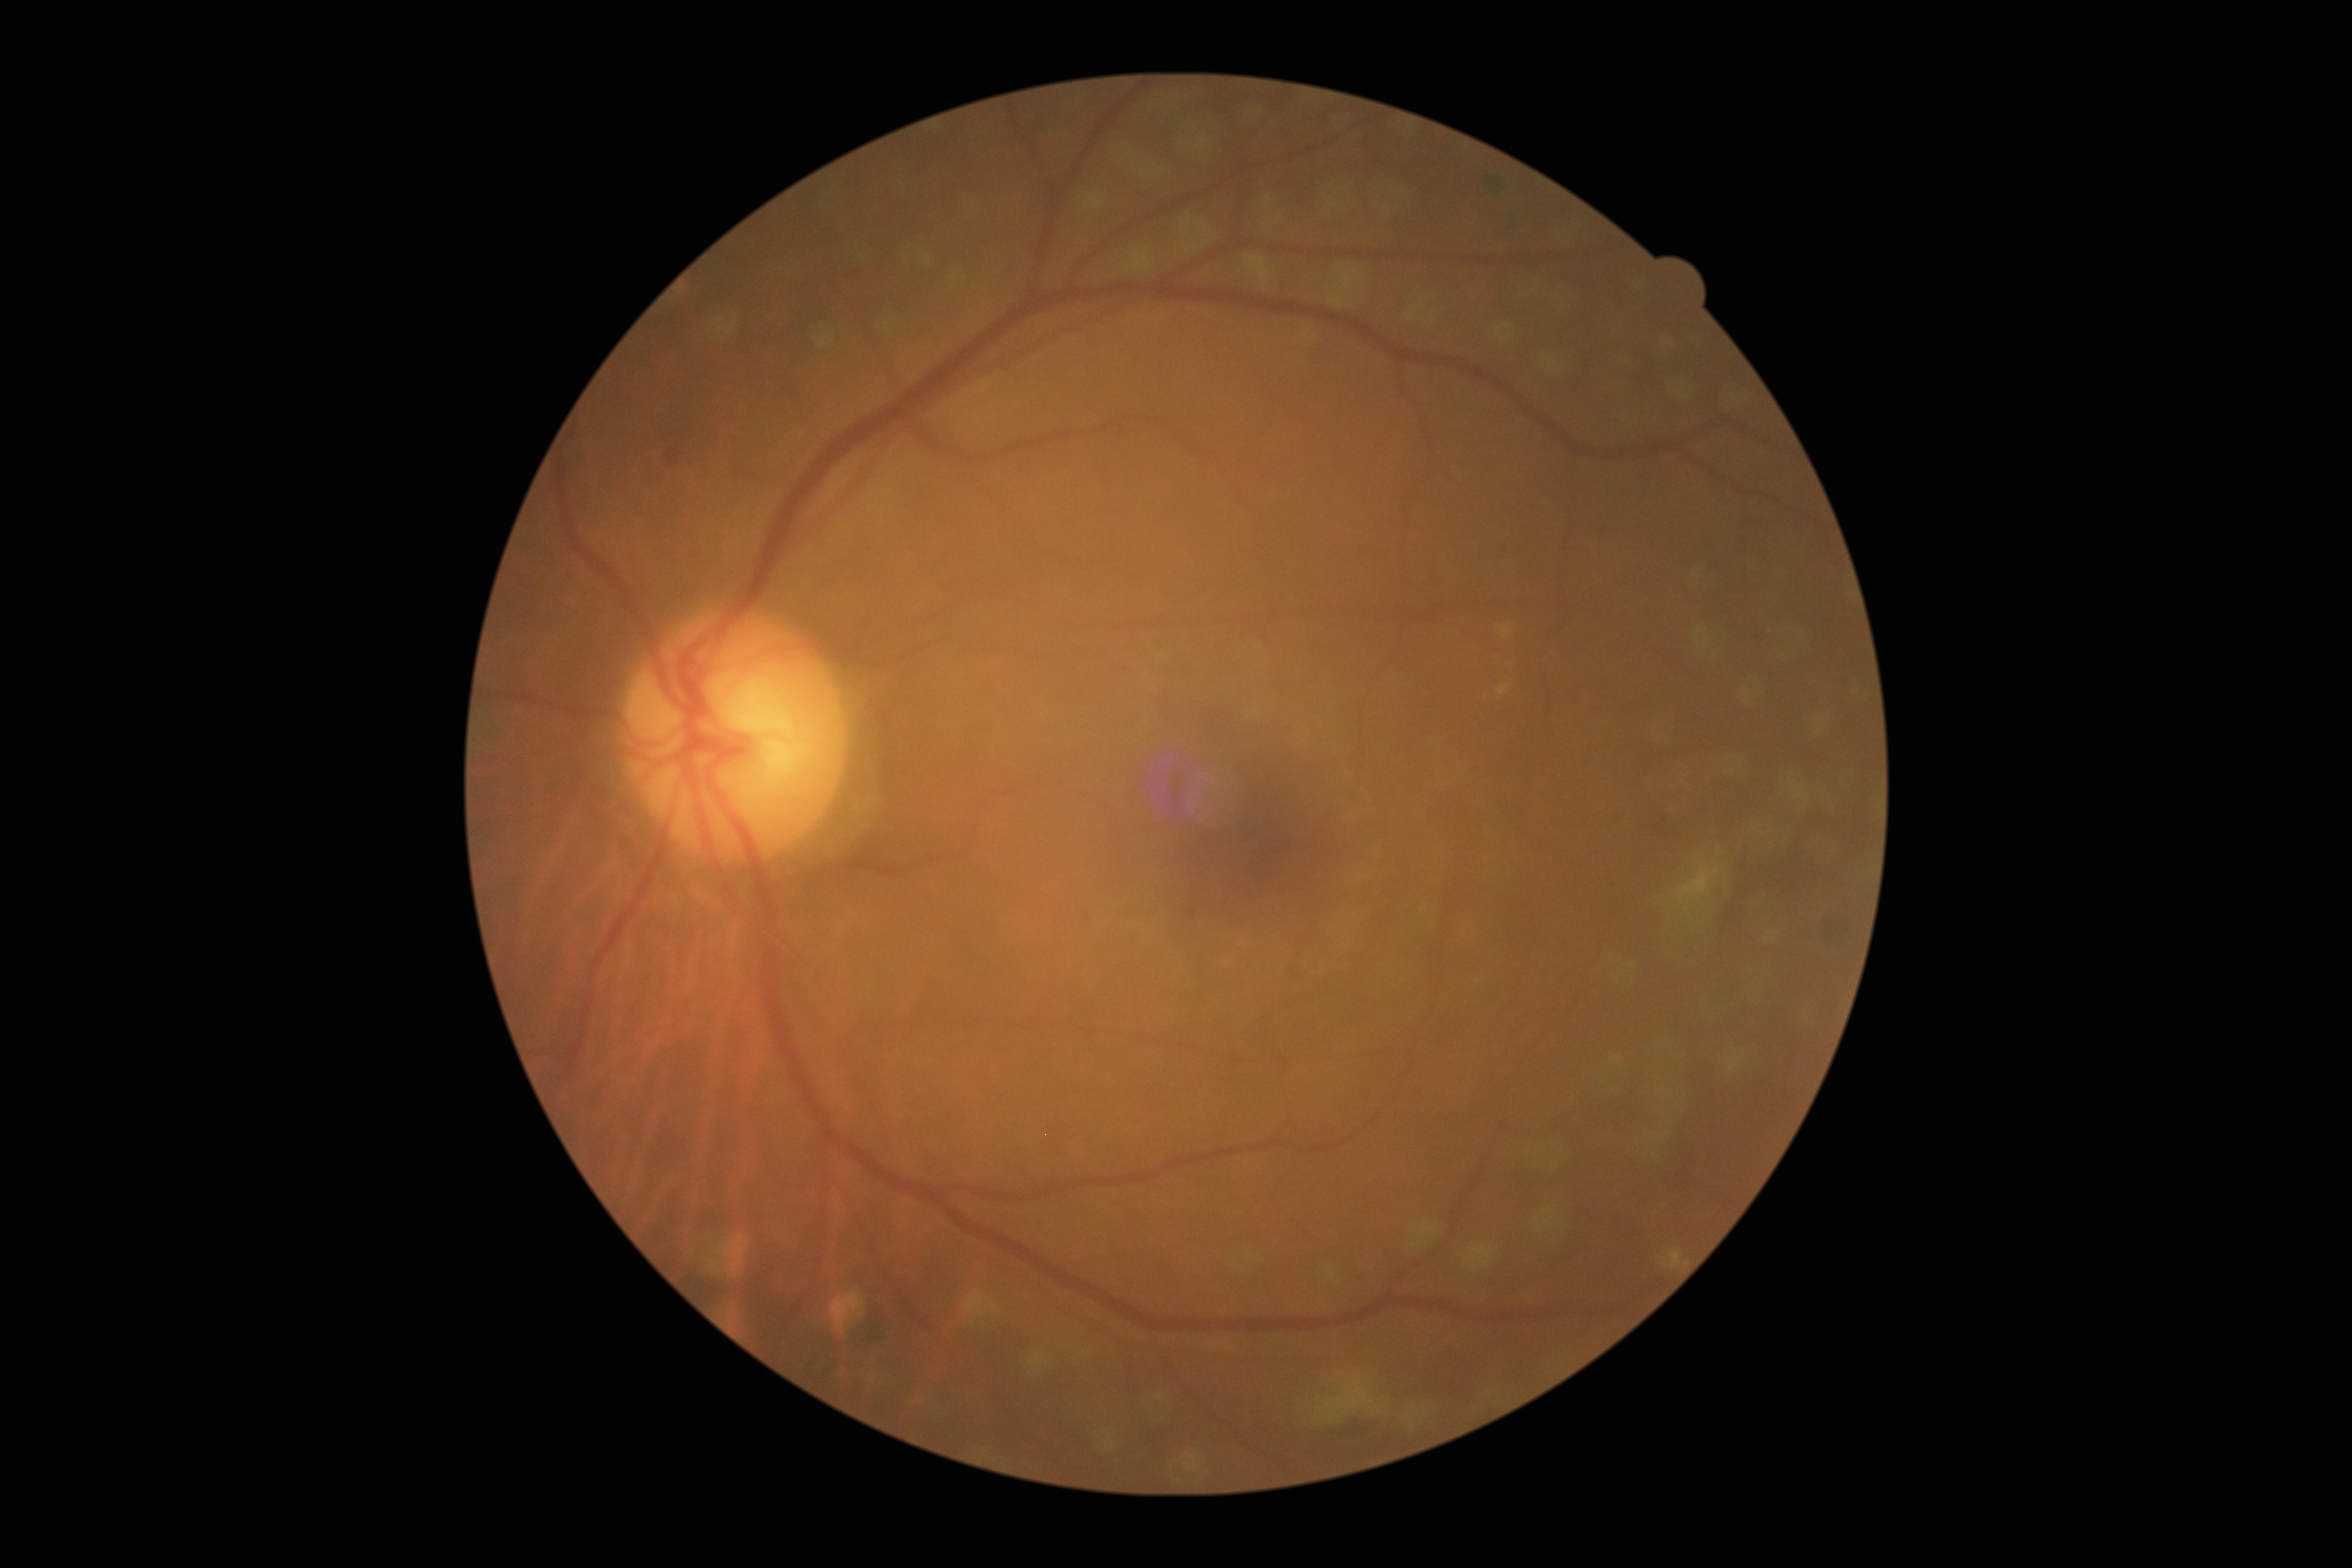 DR class: non-proliferative diabetic retinopathy; DR stage: grade 2 (moderate NPDR).